Davis DR grading · image size 848x848 · 45° field of view.
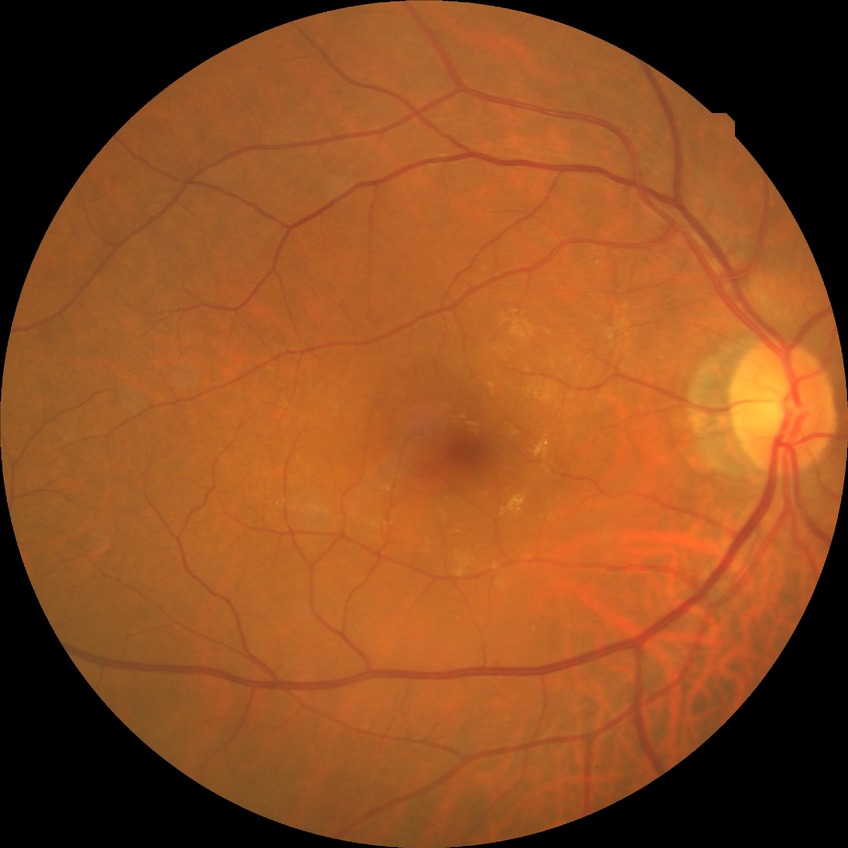
Davis DR grade is NDR. No apparent diabetic retinopathy.